45-degree field of view; NIDEK AFC-230; posterior pole photograph — 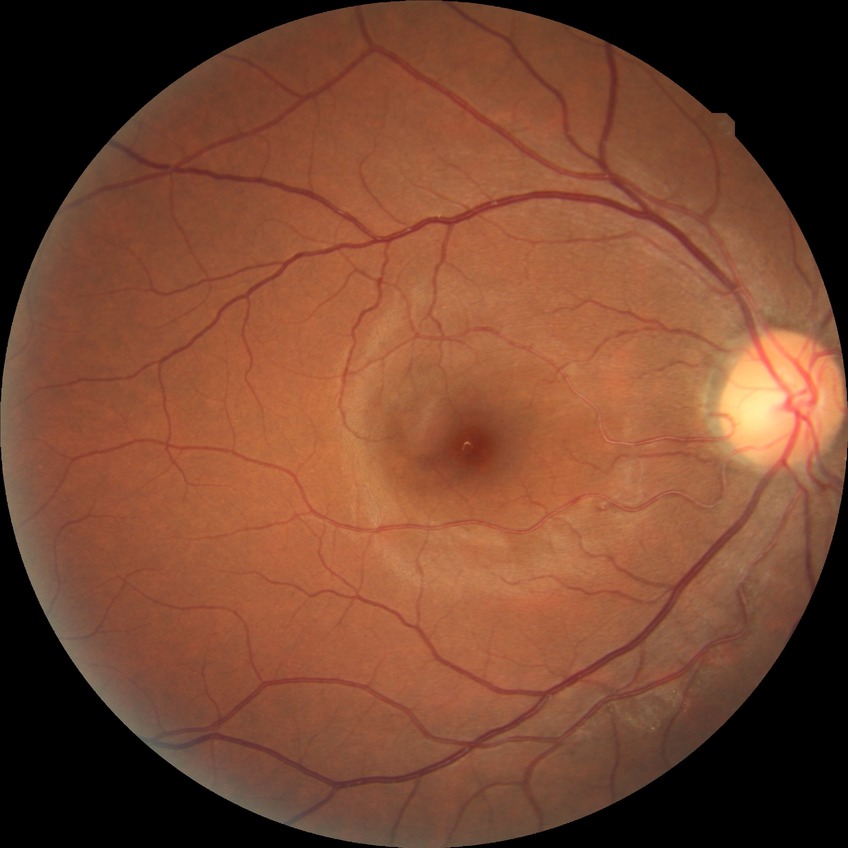

diabetic retinopathy grade = no diabetic retinopathy.